Nonmydriatic · acquired with a NIDEK AFC-230:
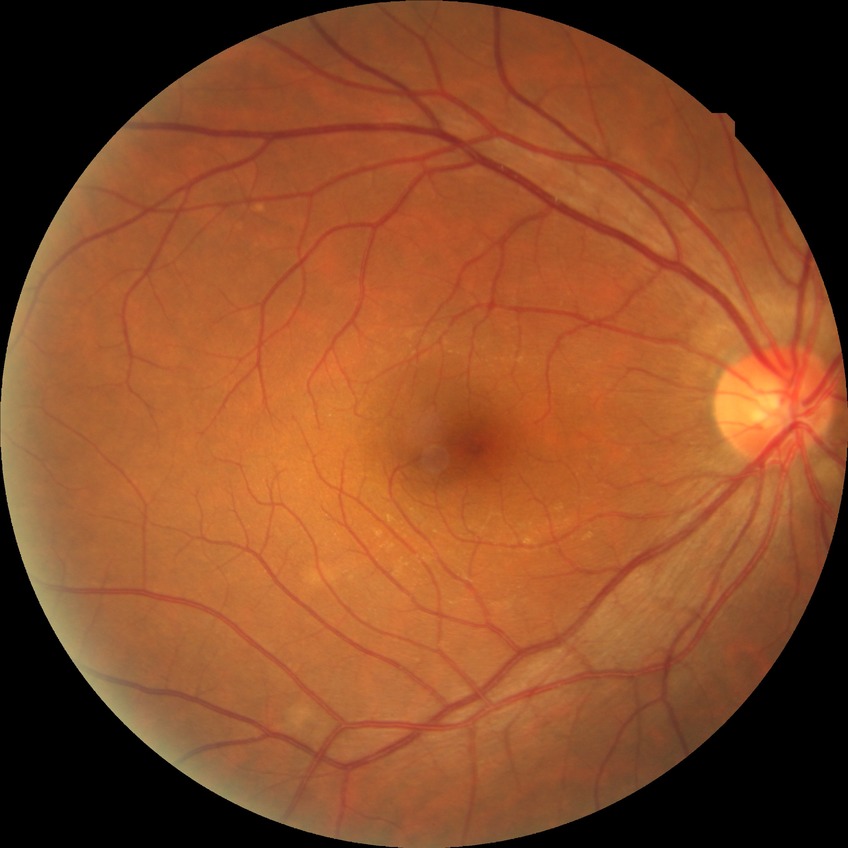 davis_grade: NDR (no diabetic retinopathy)